2346x1568; FOV: 45 degrees: 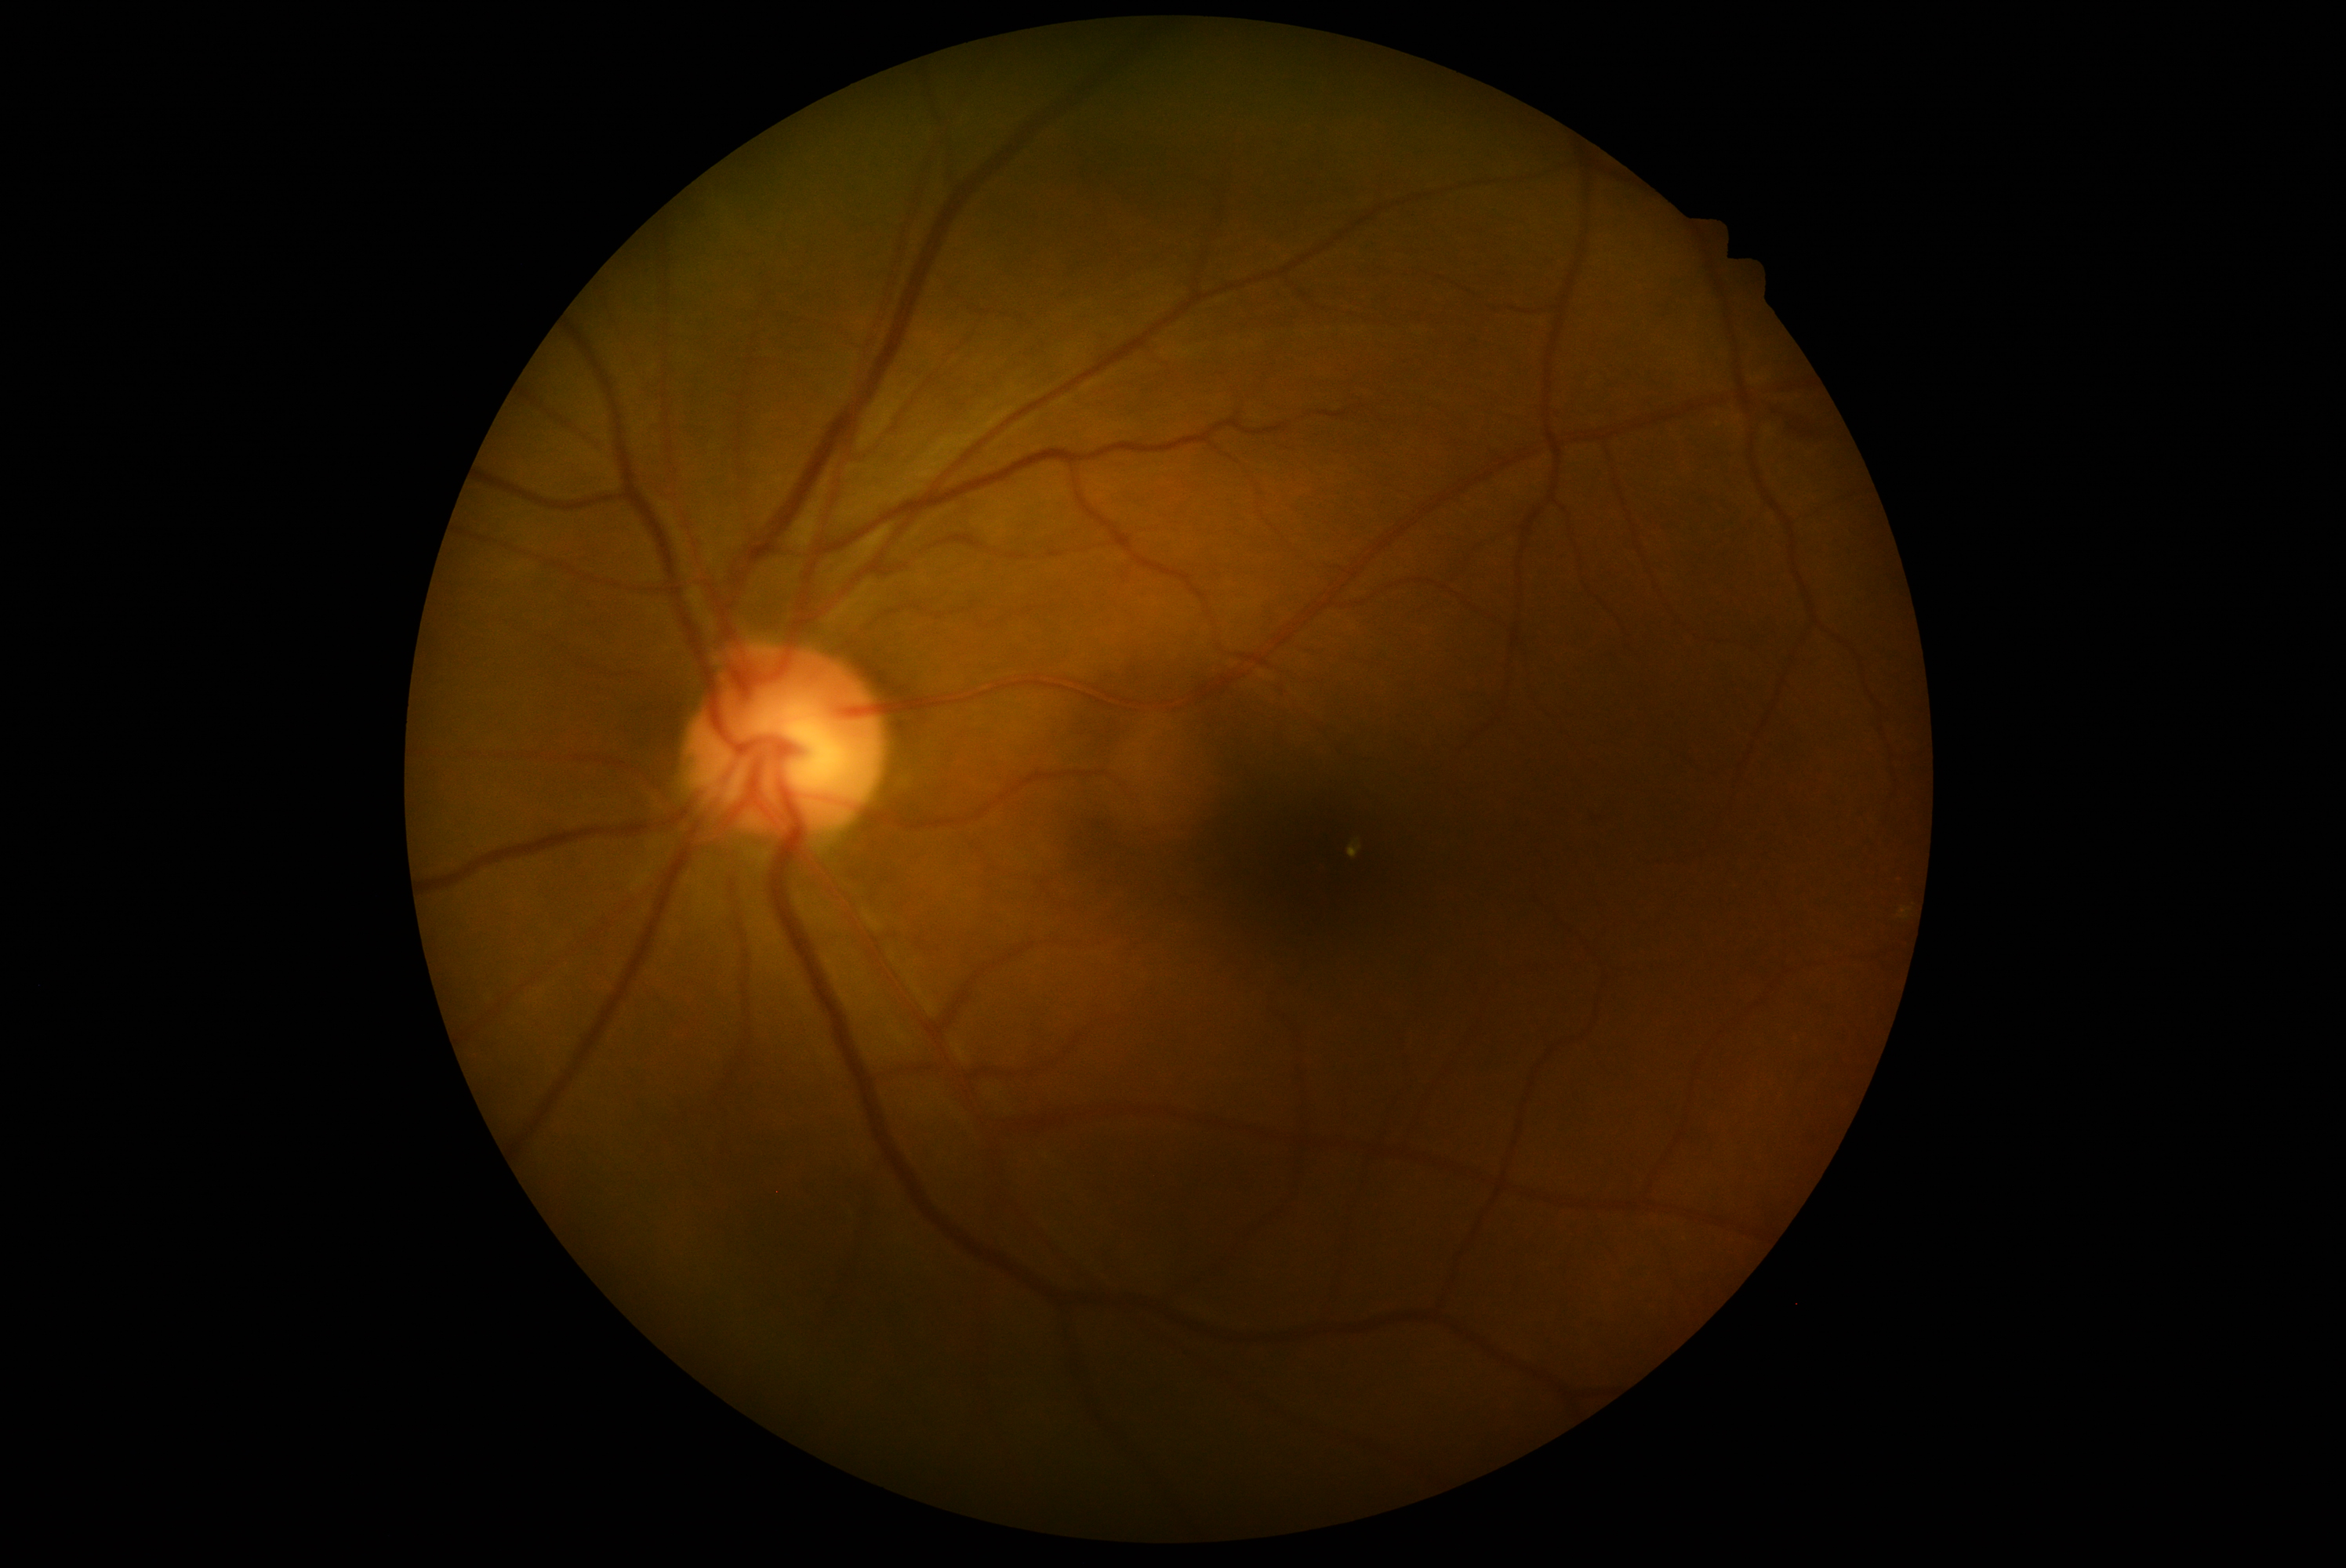
{"dr_grade": "2/4 — more than just microaneurysms but less than severe NPDR"}